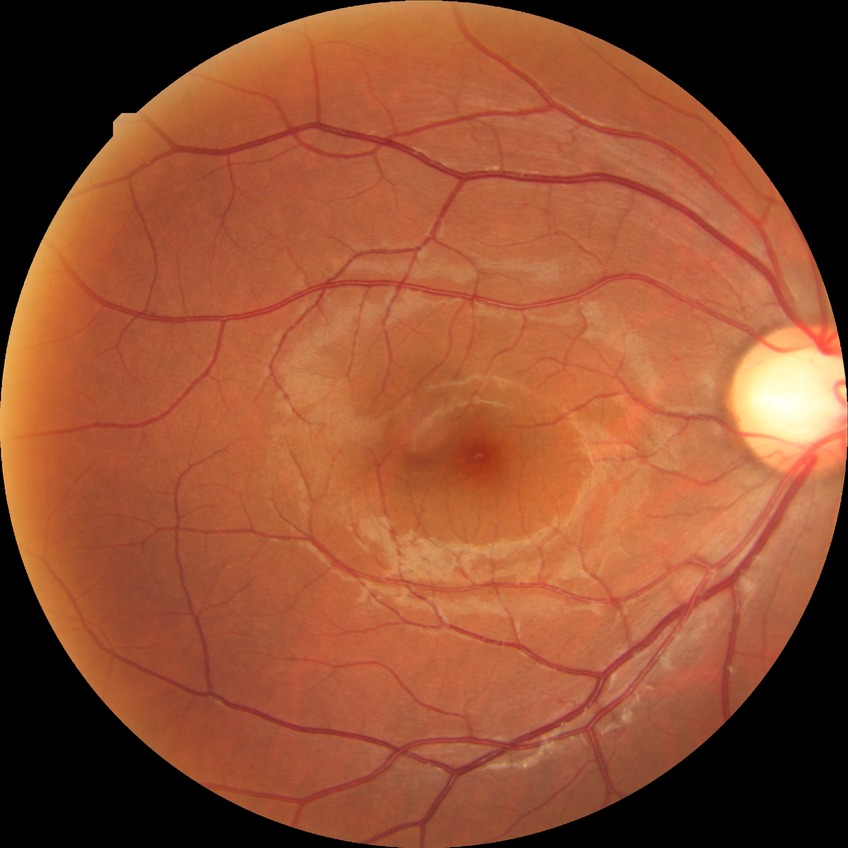

Diabetic retinopathy (DR) is NDR (no diabetic retinopathy).